FOV: 45 degrees.
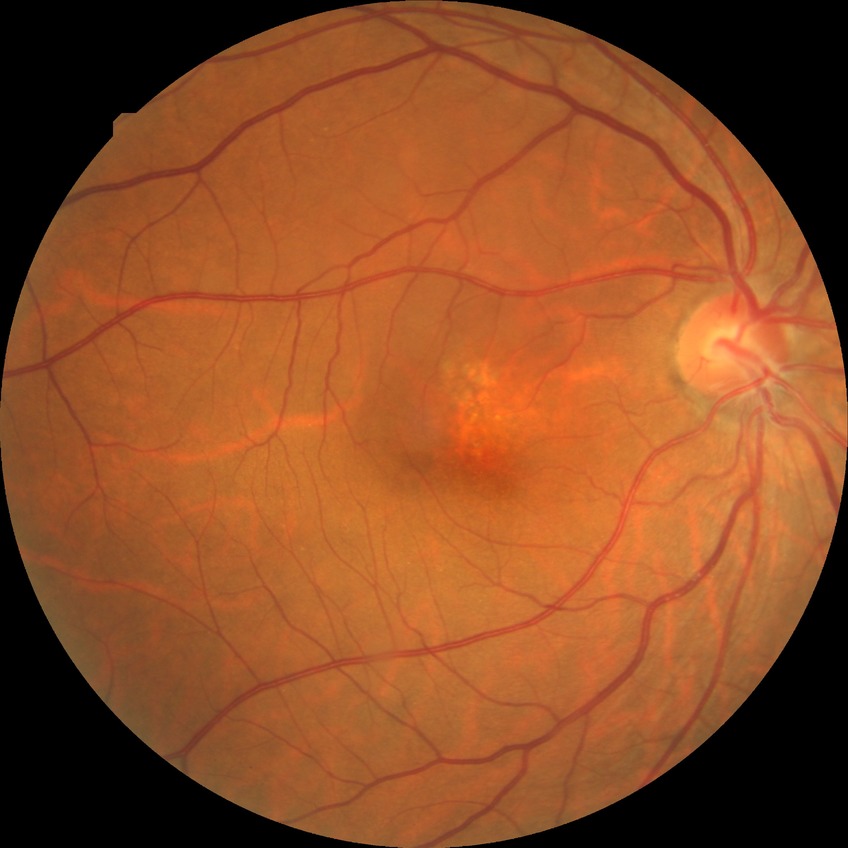
No DR findings. Davis grade is NDR.